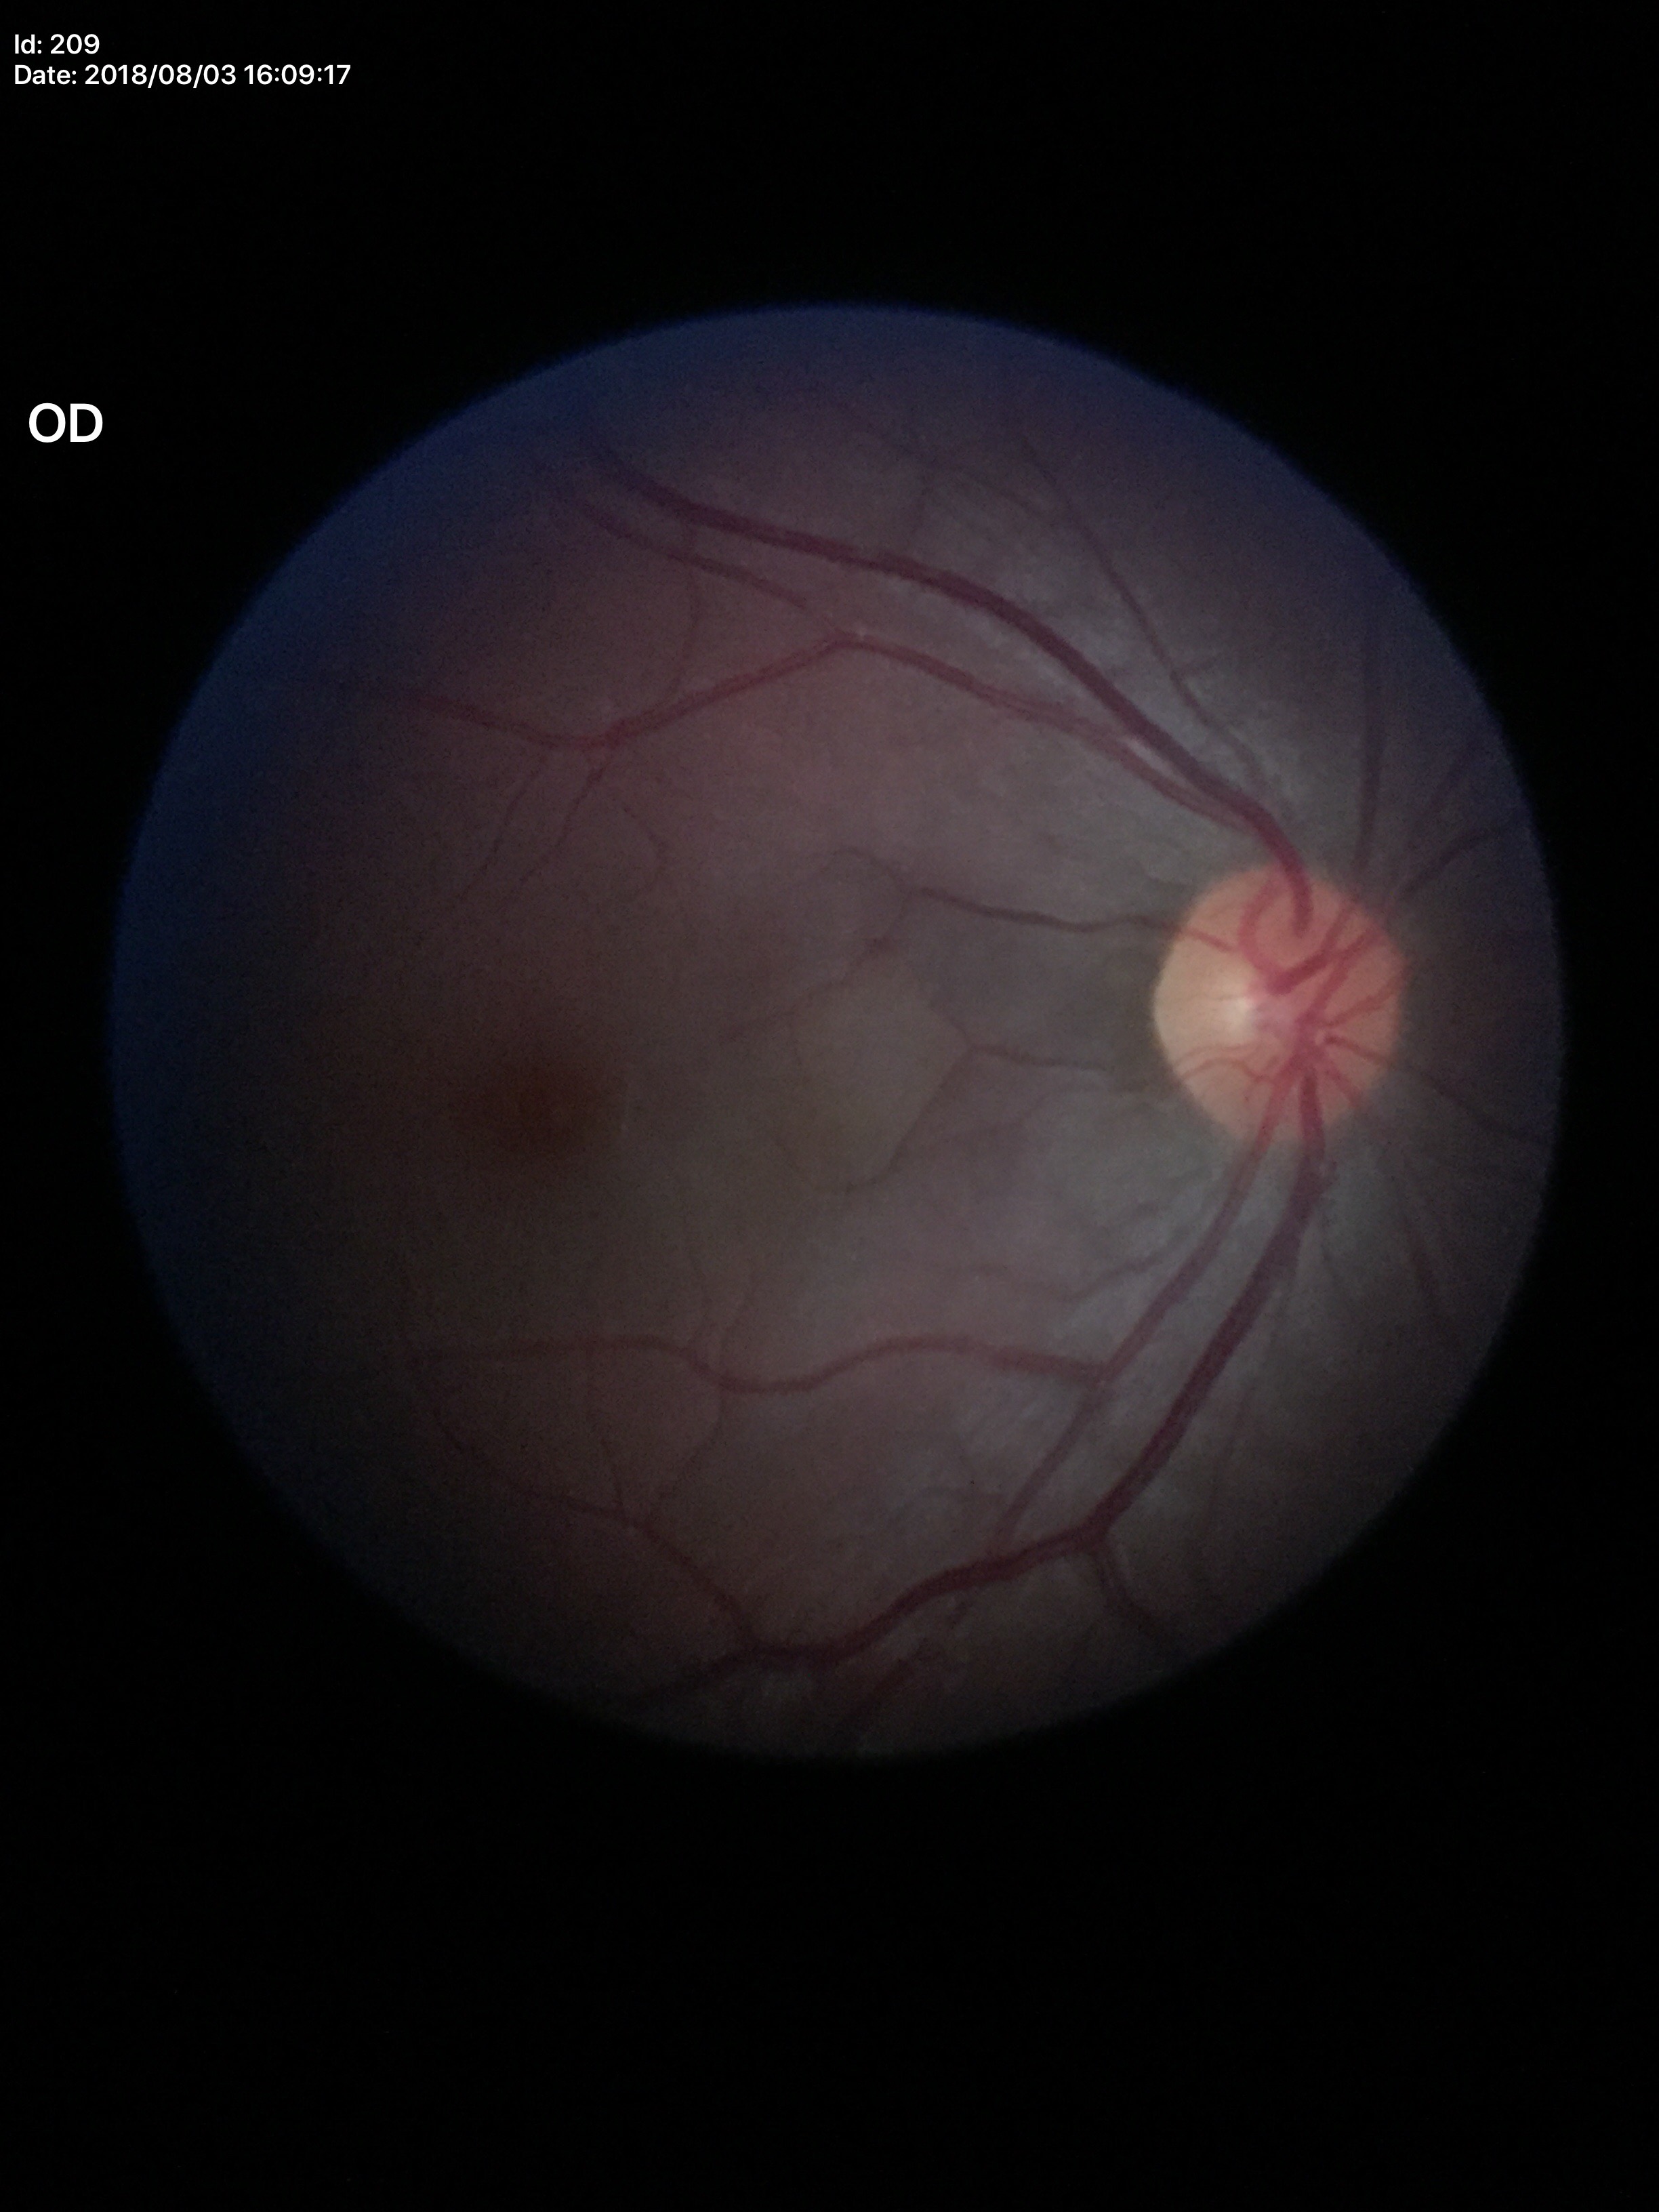
Annotations:
* horizontal cup-disc ratio (HCDR) · 0.47
* vertical cup-disc ratio (VCDR) · 0.50
* Glaucoma screening impression · no suspicious findings